45° FOV: 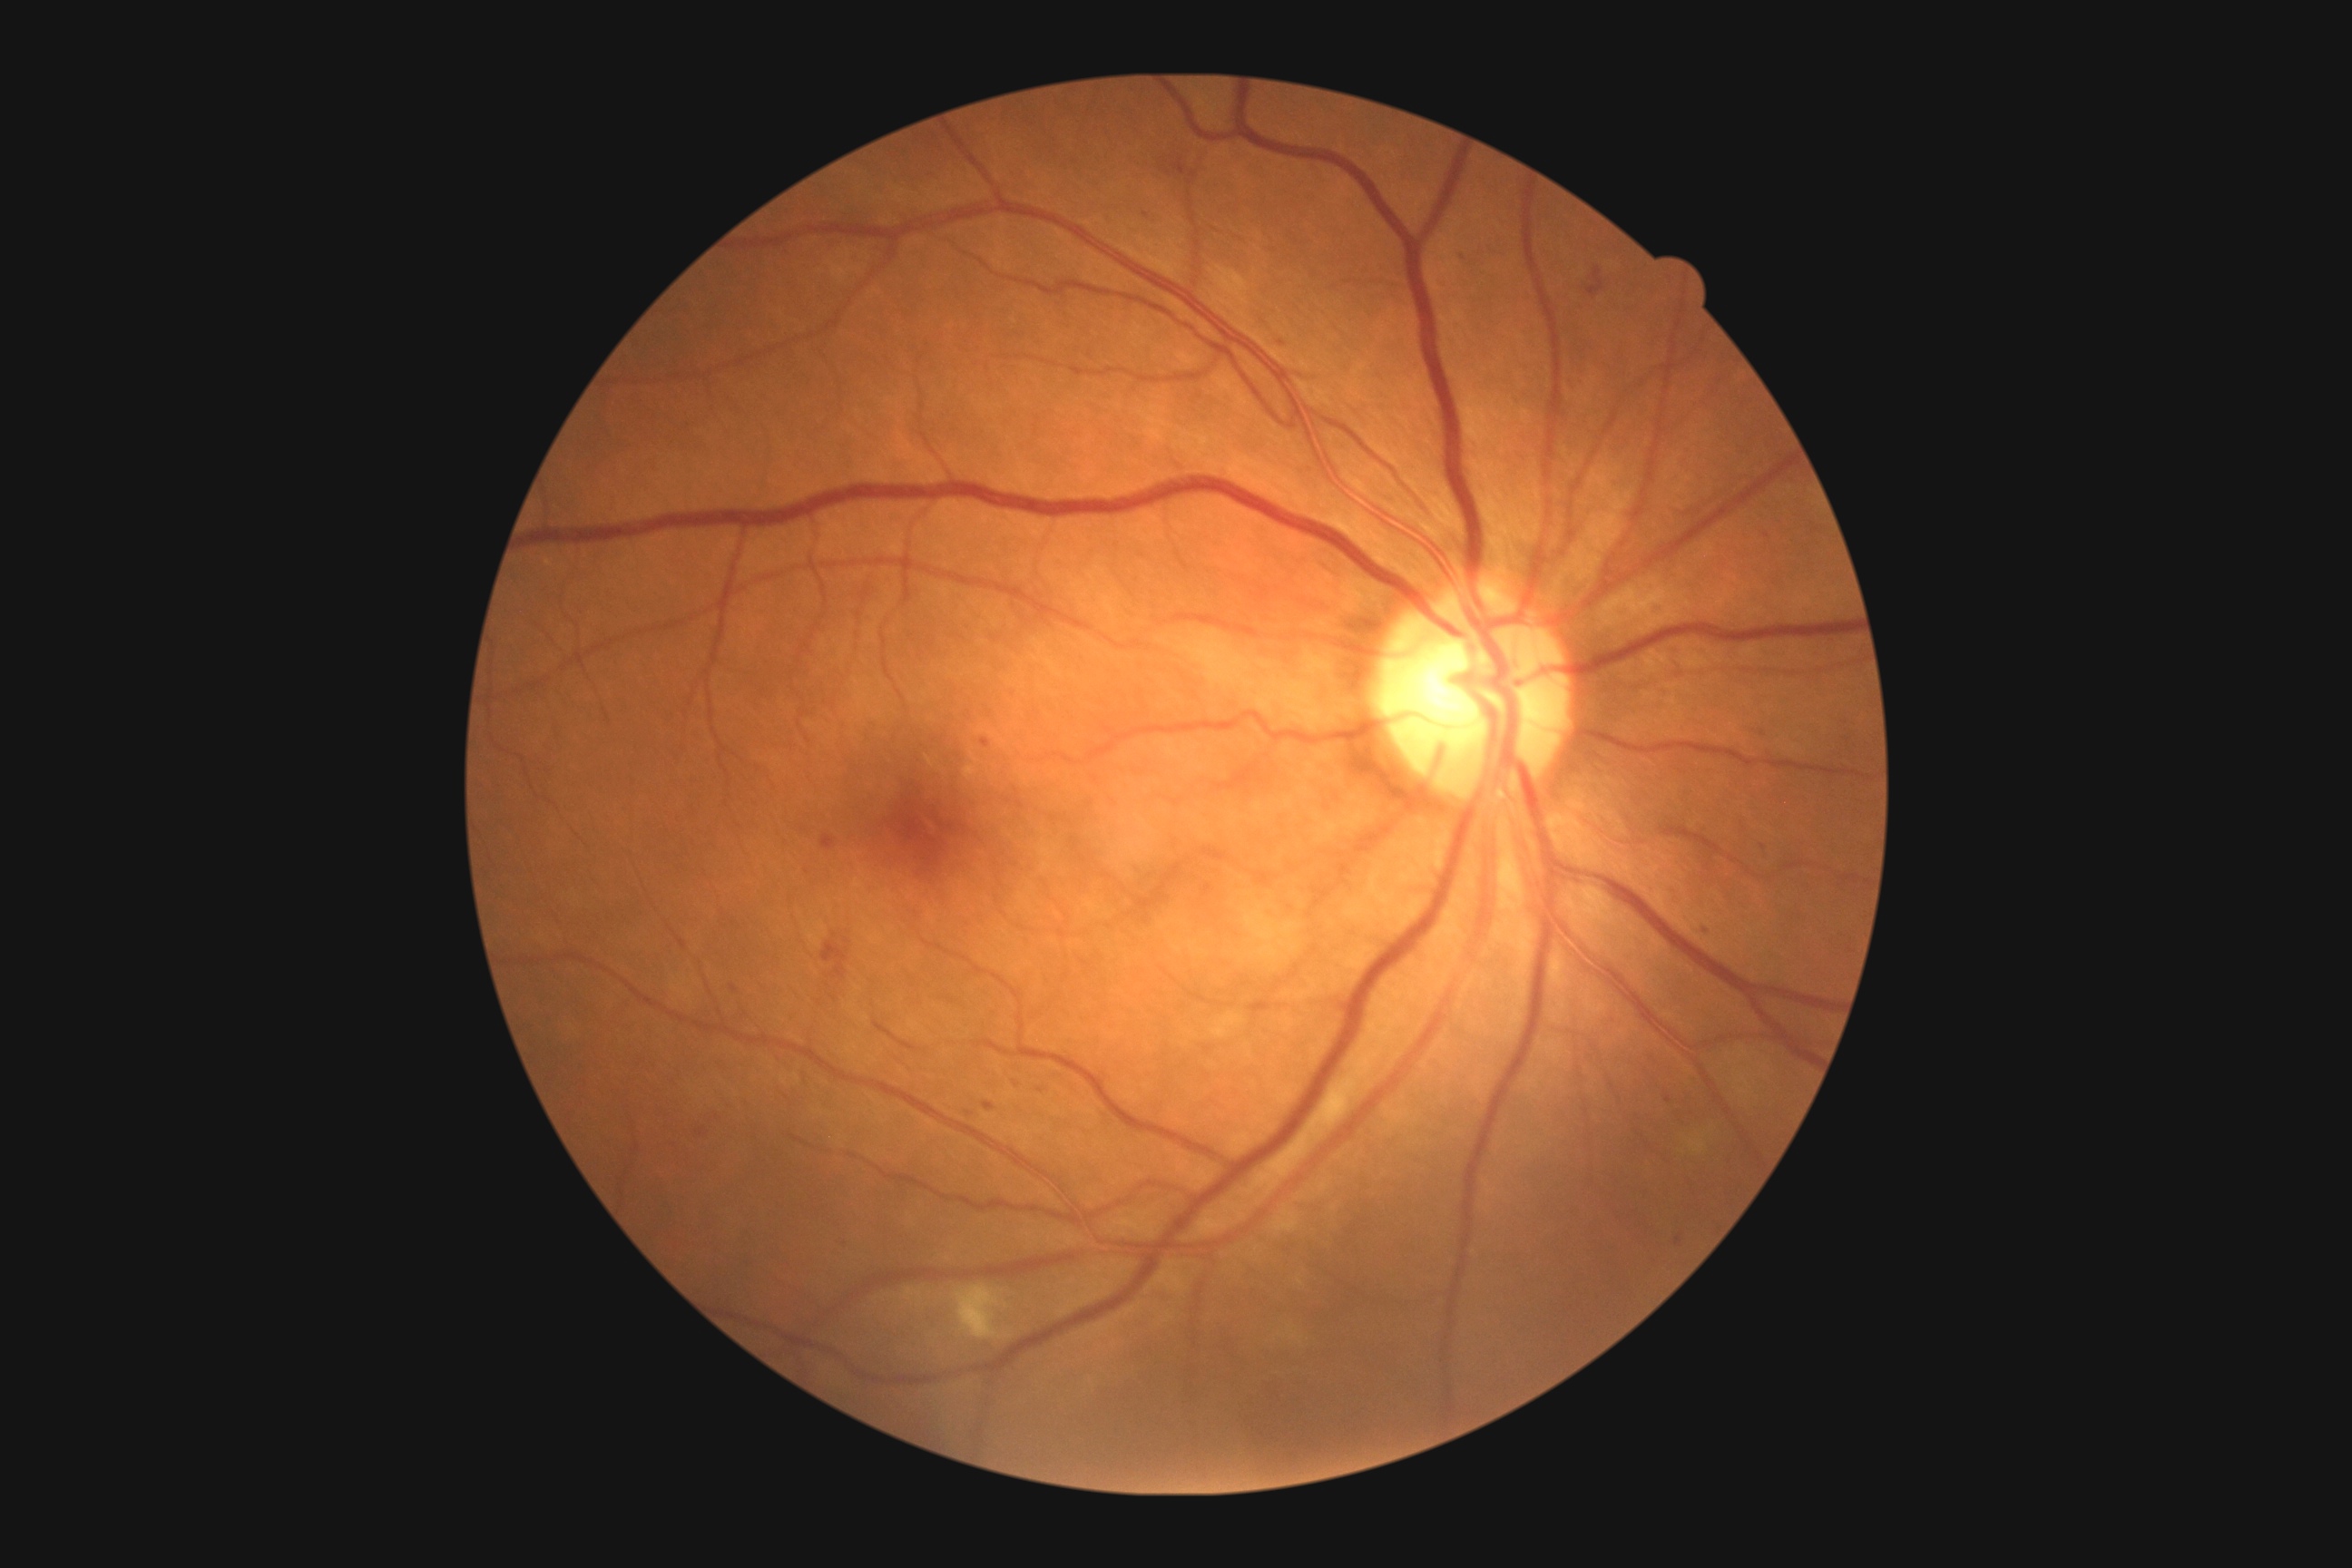
DR stage: grade 2.